2352 by 1568 pixels. Color fundus photograph — 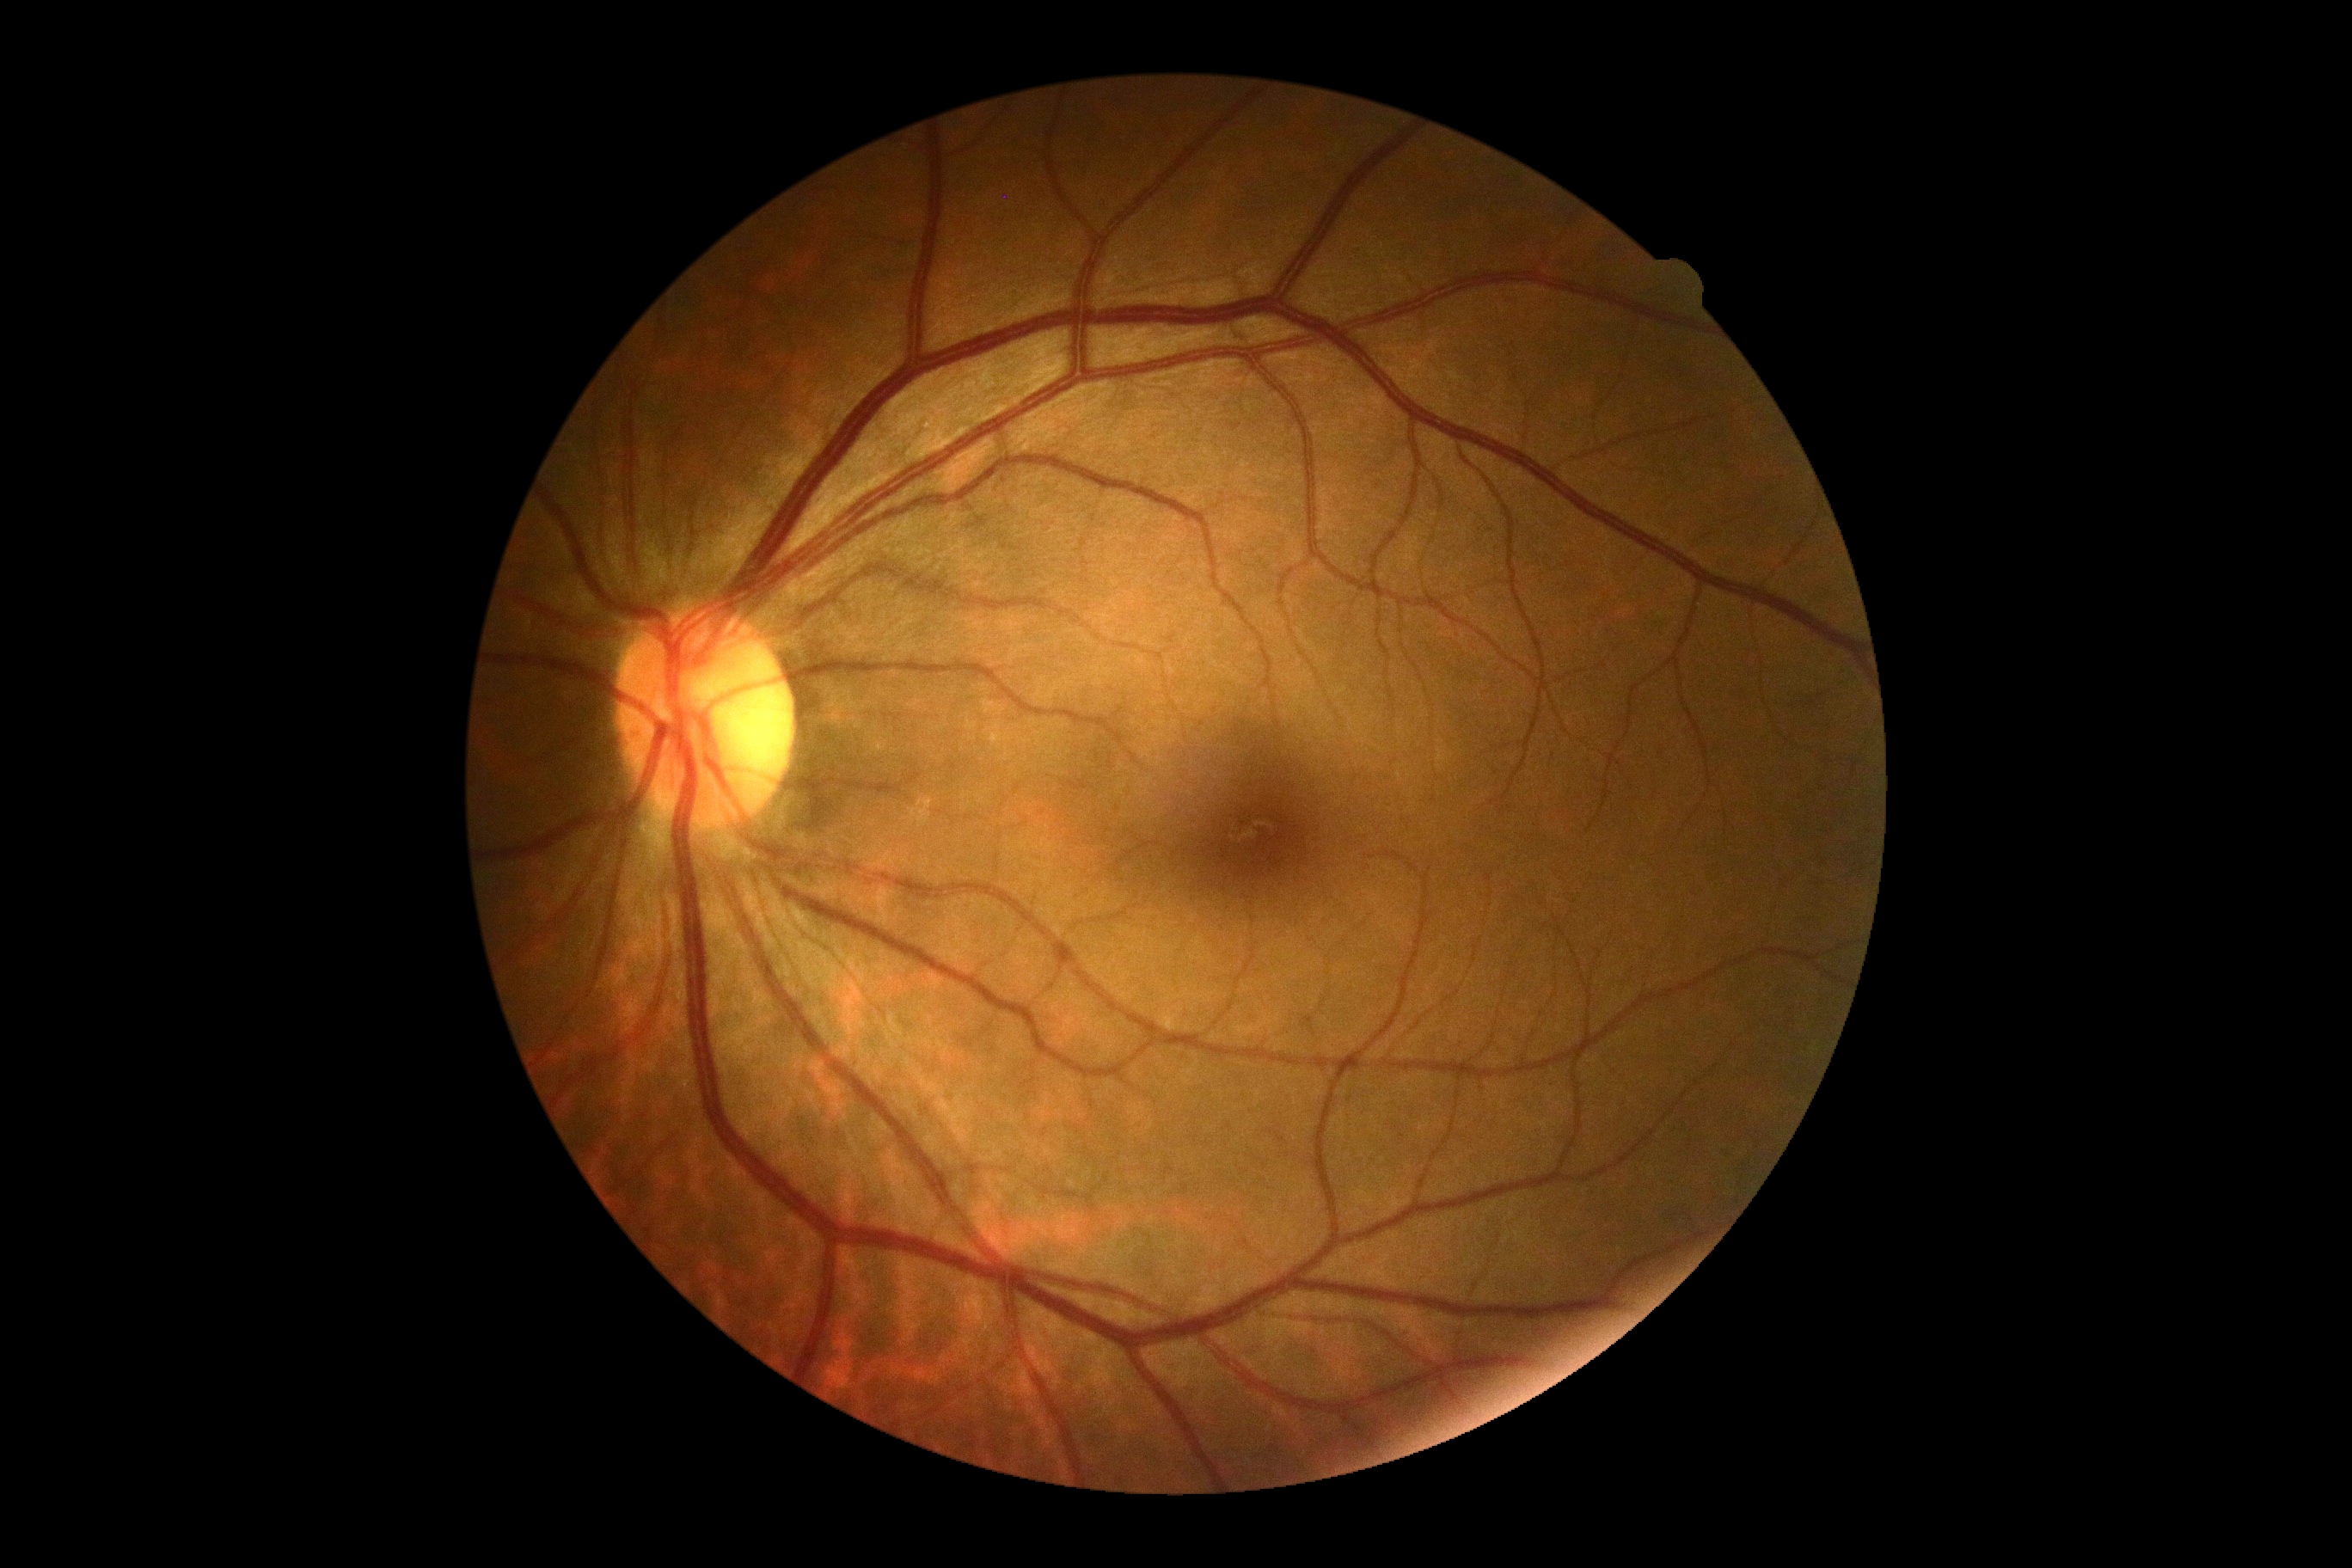 Annotations:
• DR impression: no apparent DR
• DR stage: no apparent retinopathy (grade 0)